Without pupil dilation, 45-degree field of view, acquired with a NIDEK AFC-230
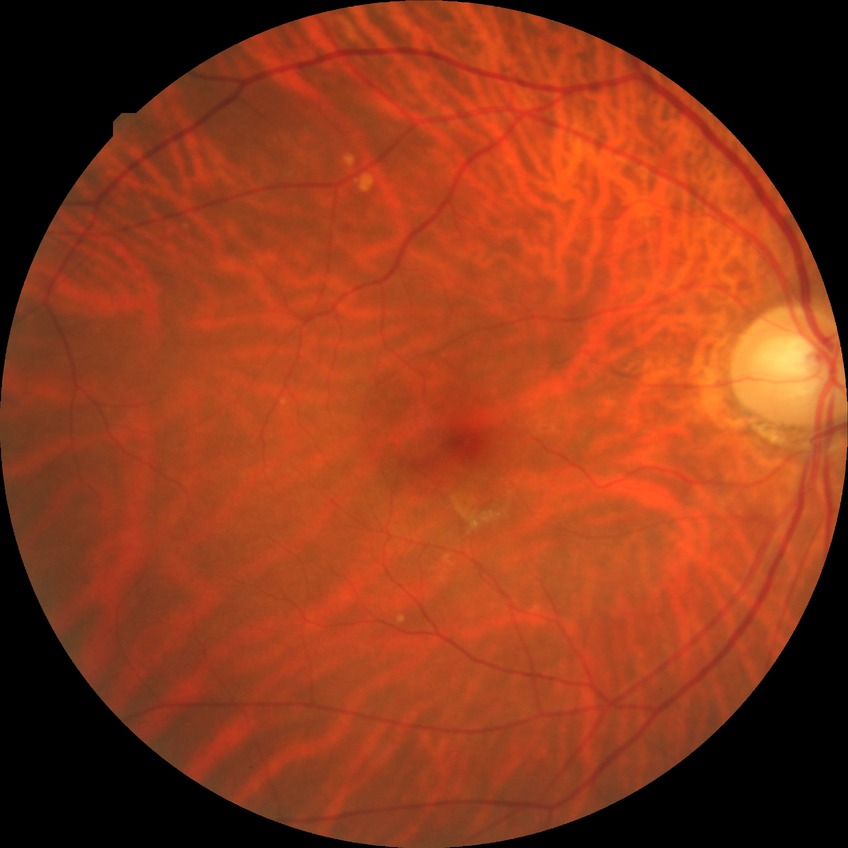 Diabetic retinopathy (DR): NDR (no diabetic retinopathy).